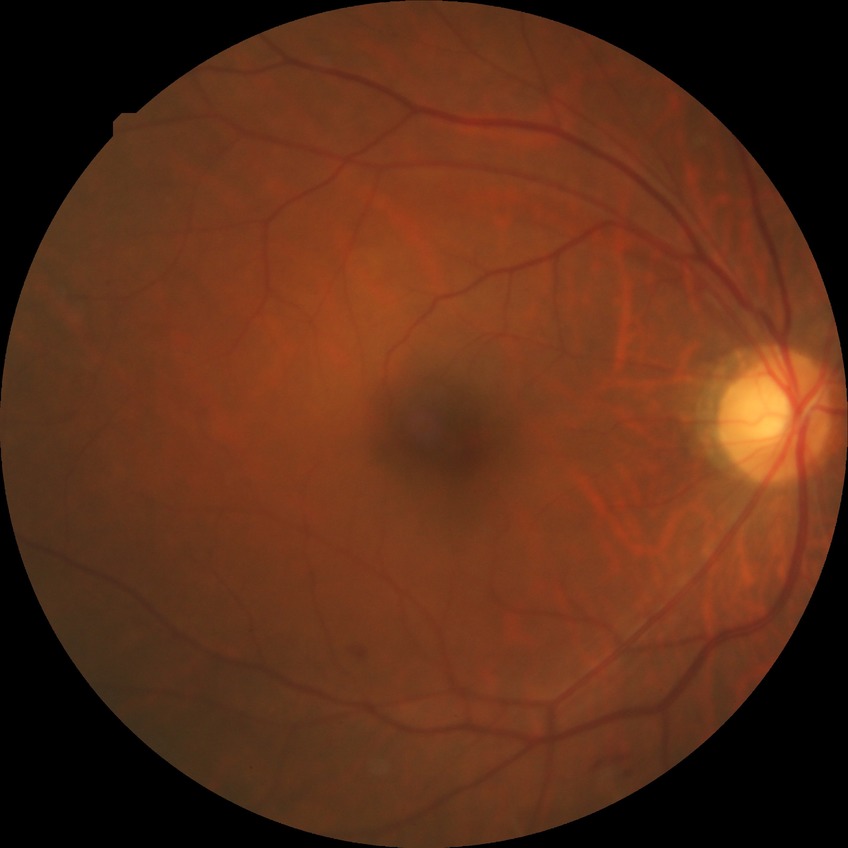
diabetic retinopathy (DR): simple diabetic retinopathy (SDR).